45° FOV, fundus photo: 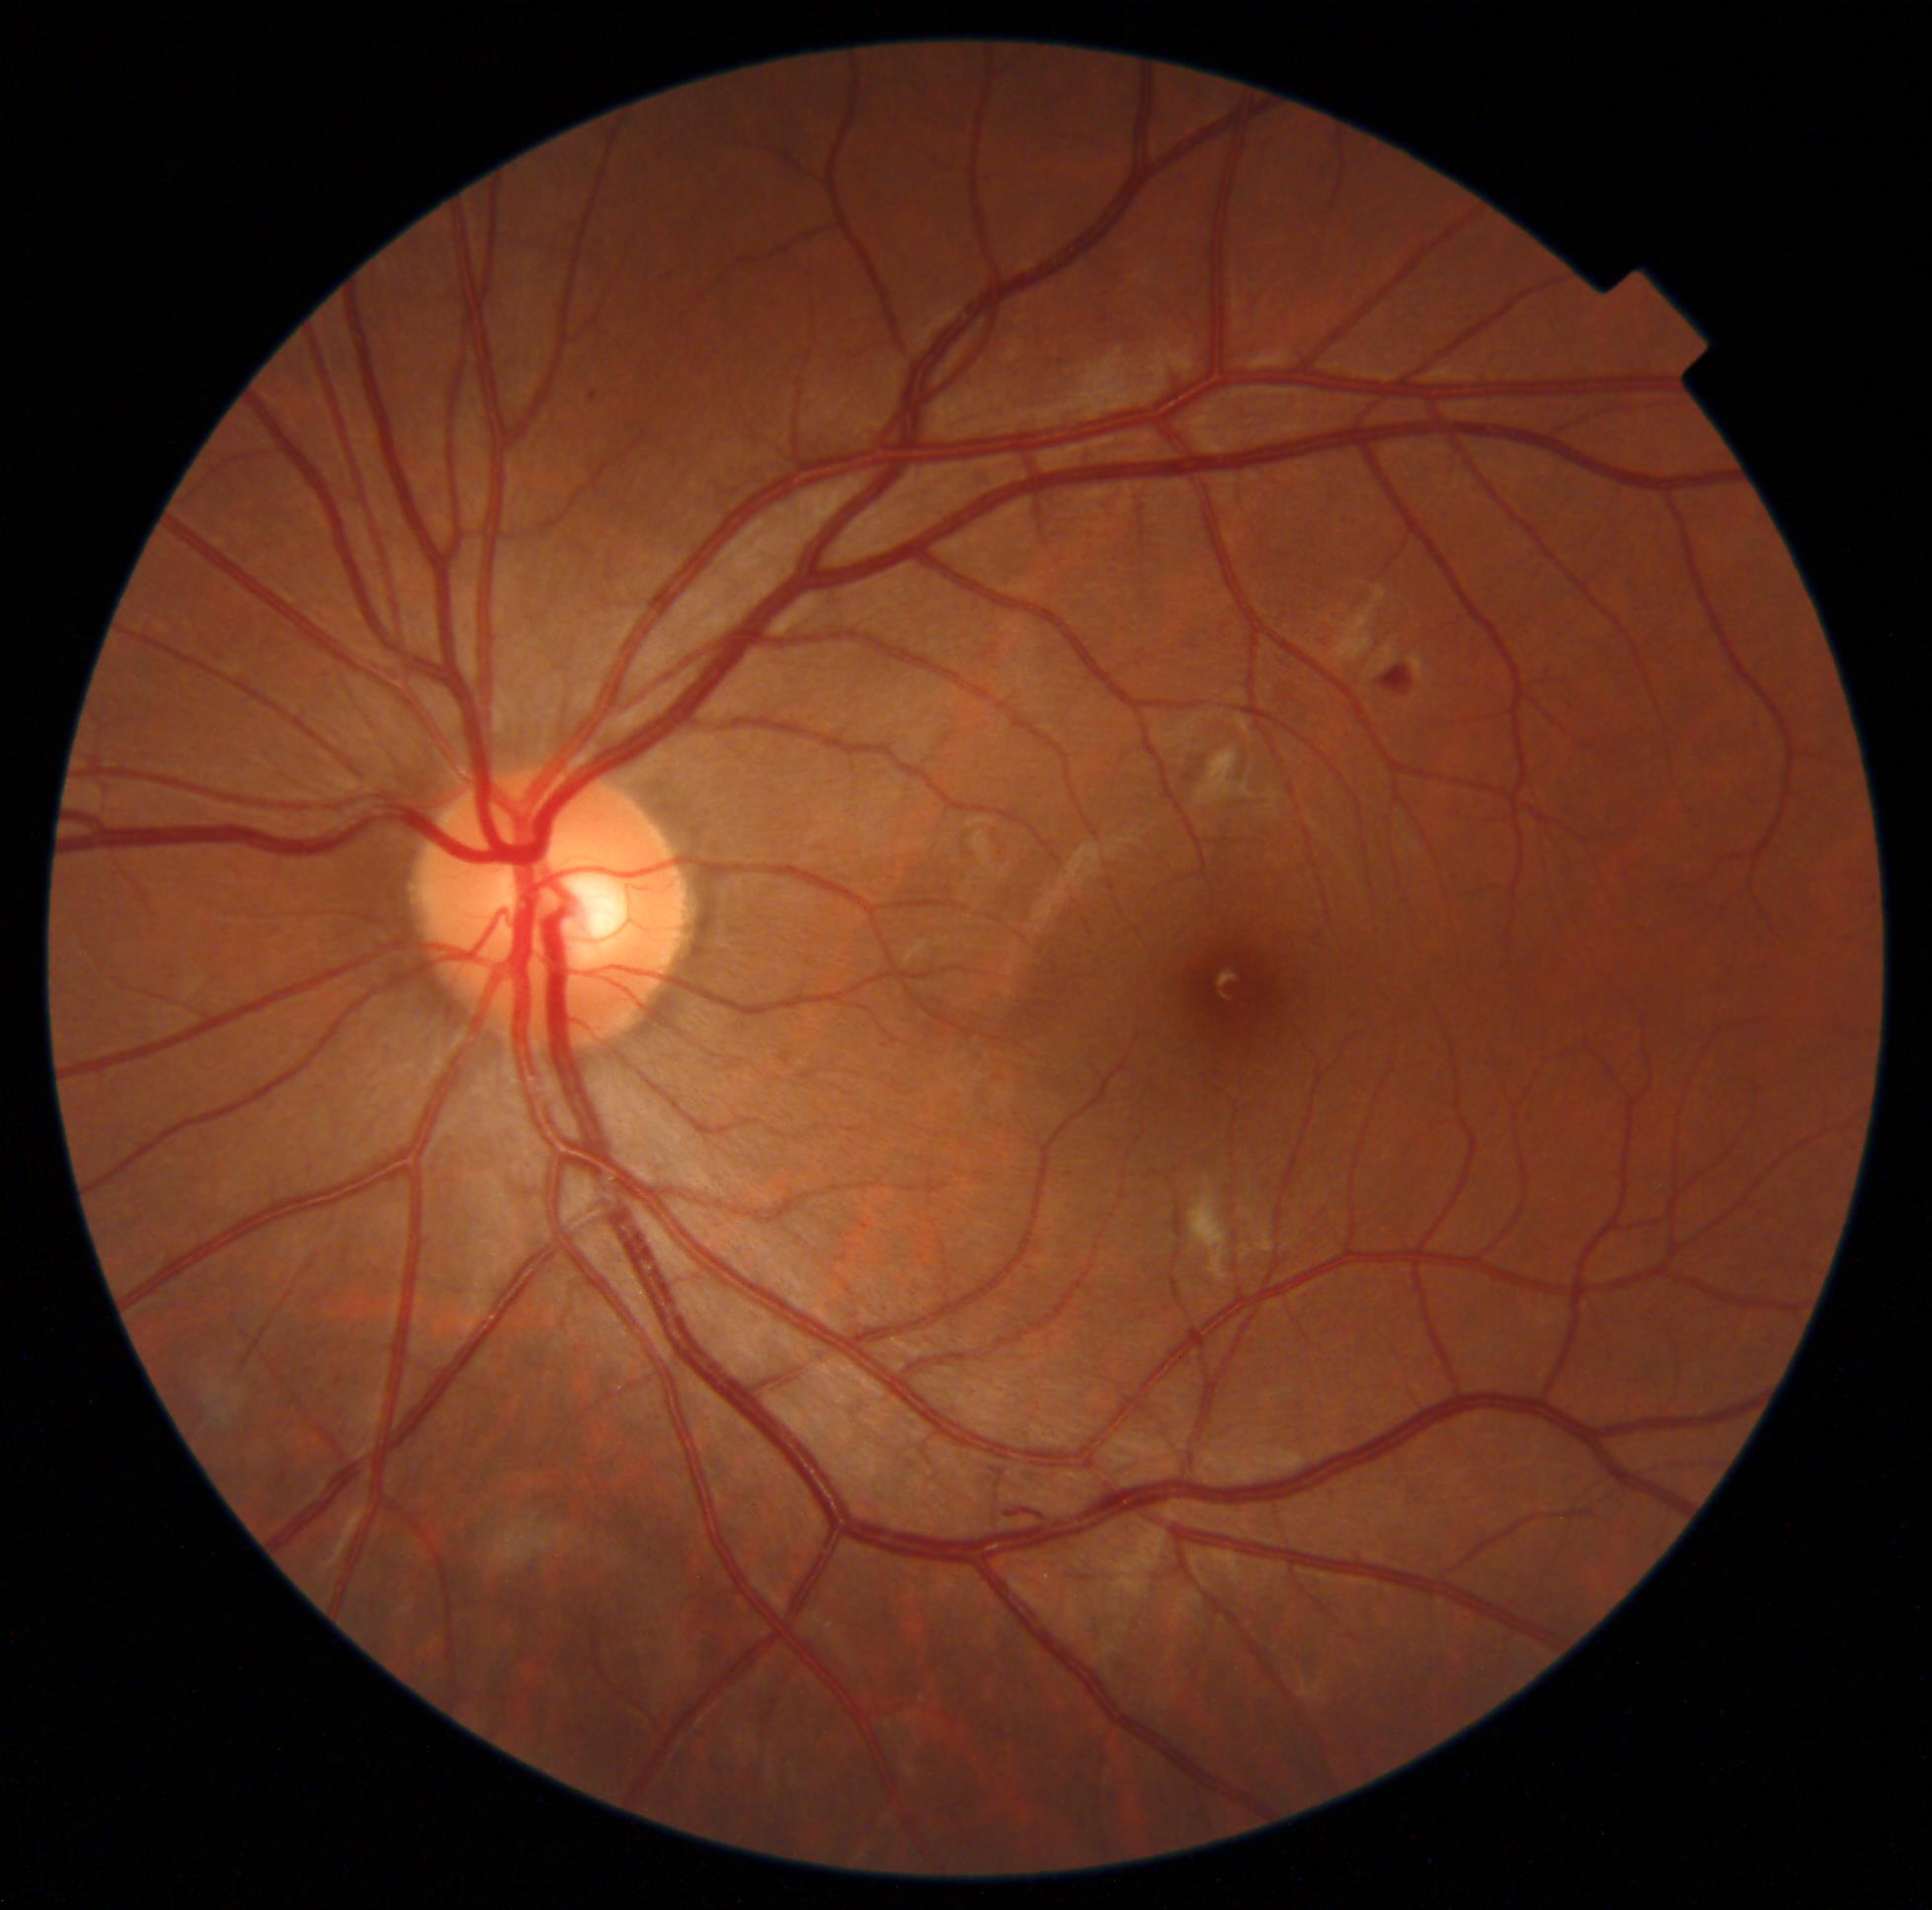 DR@grade 2.